45° field of view: 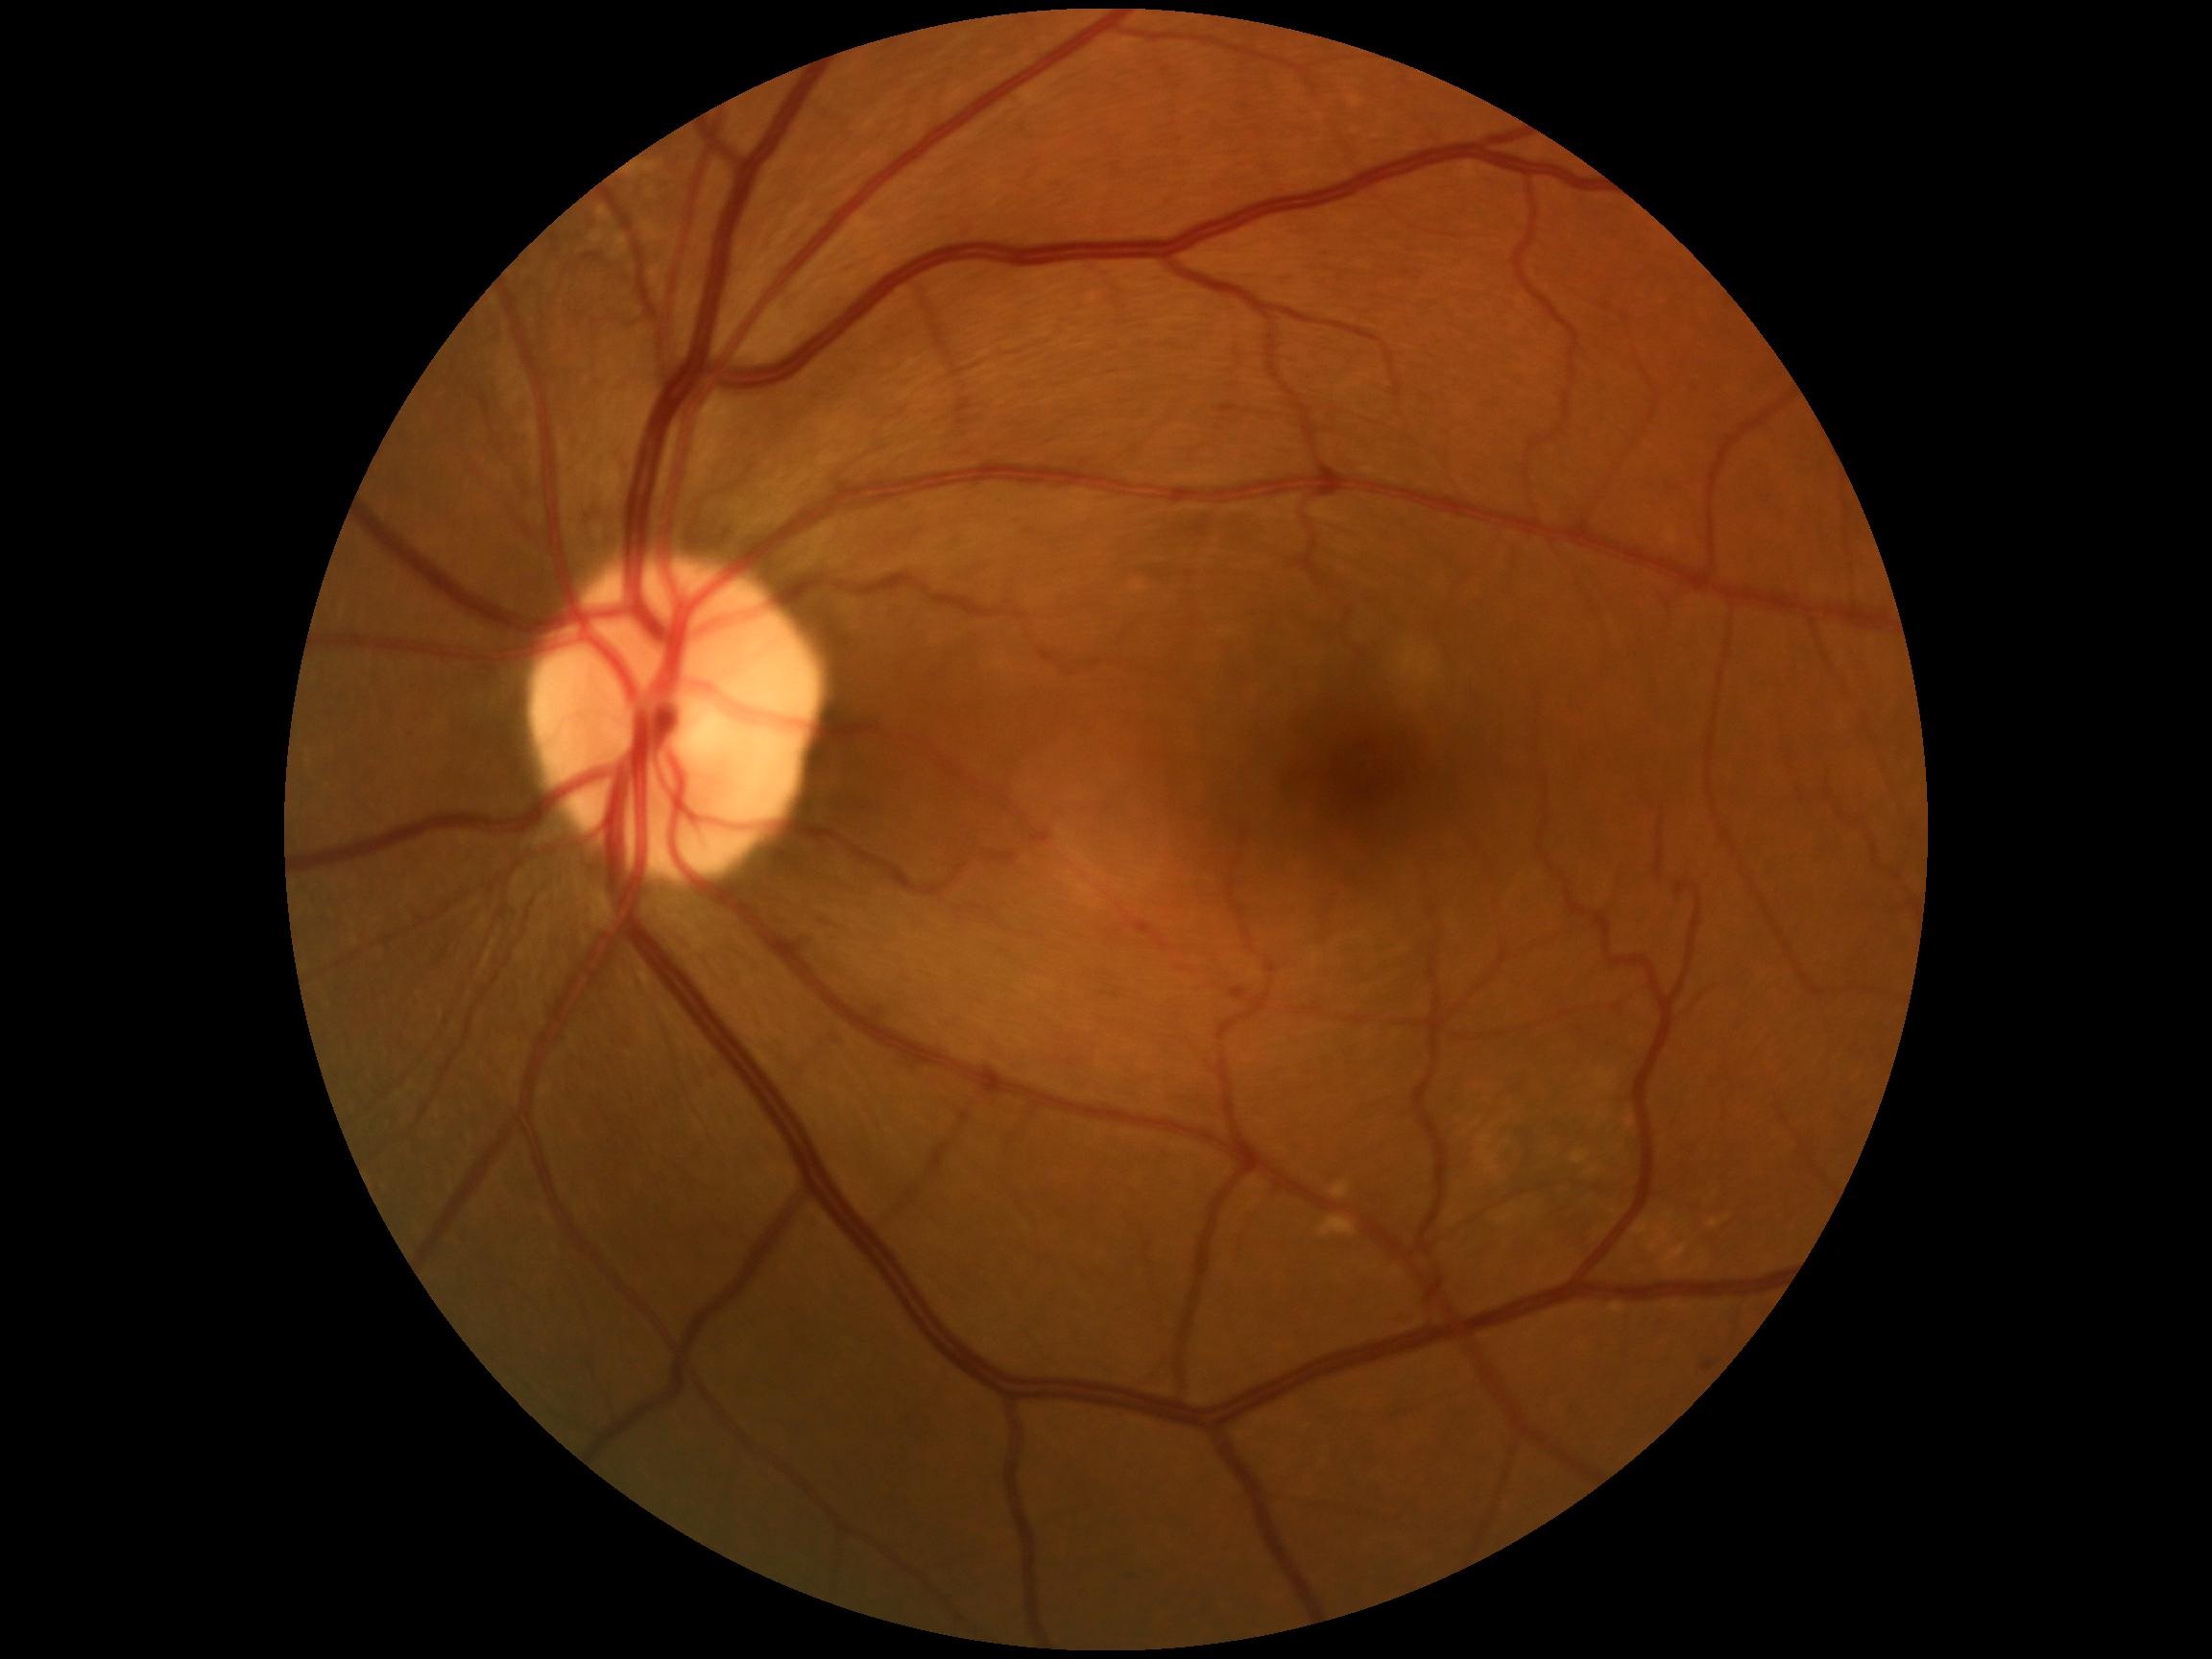

diabetic retinopathy (DR): 1 — presence of microaneurysms only.